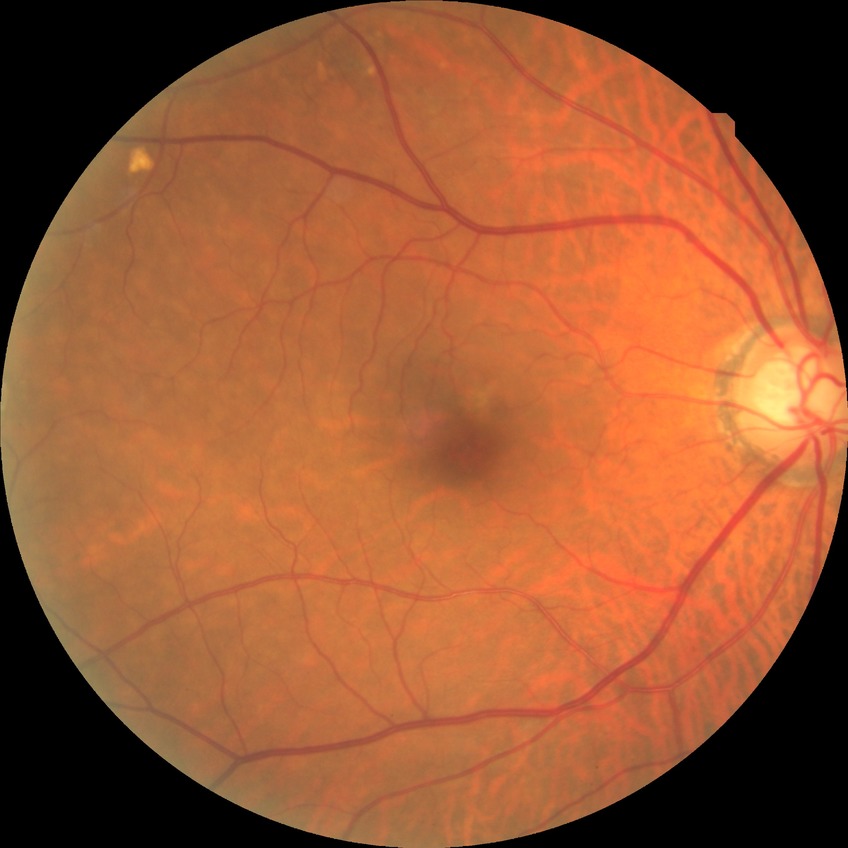
No diabetic retinal disease findings.
DR: NDR.